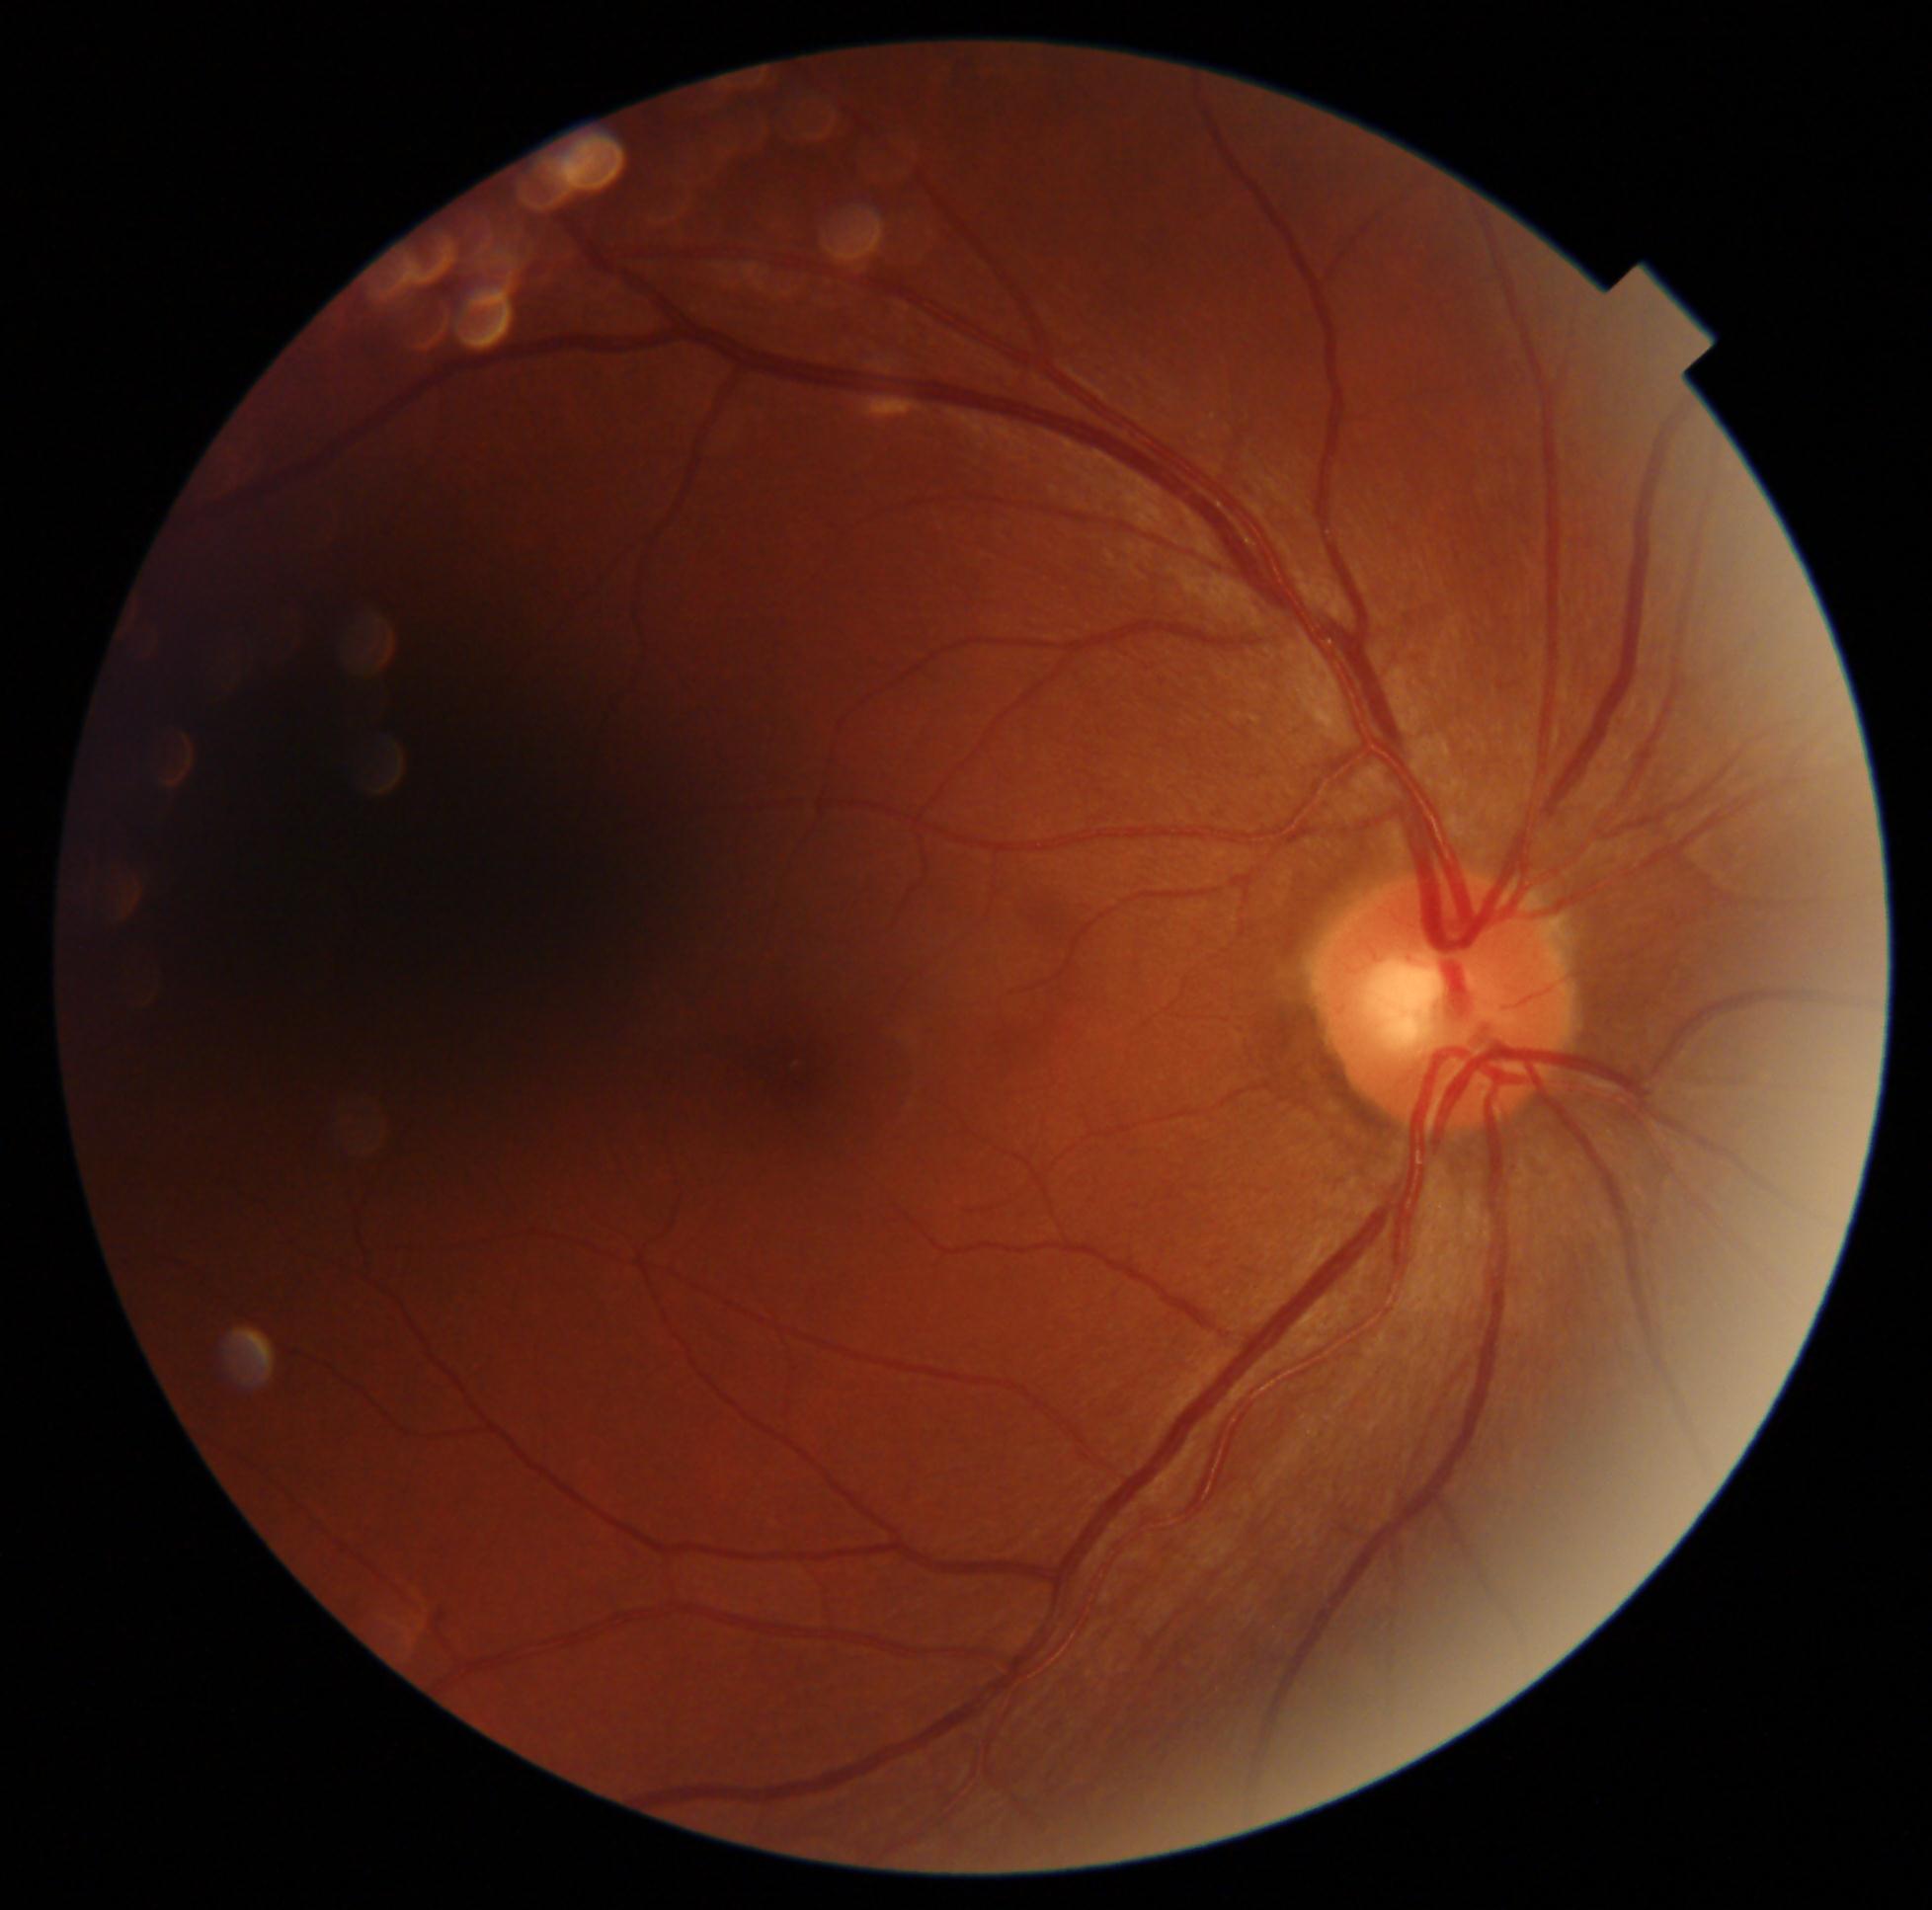

No apparent diabetic retinopathy. Diabetic retinopathy (DR): 0.